Infant wide-field fundus photograph. 1240 by 1240 pixels. Acquired on the Phoenix ICON — 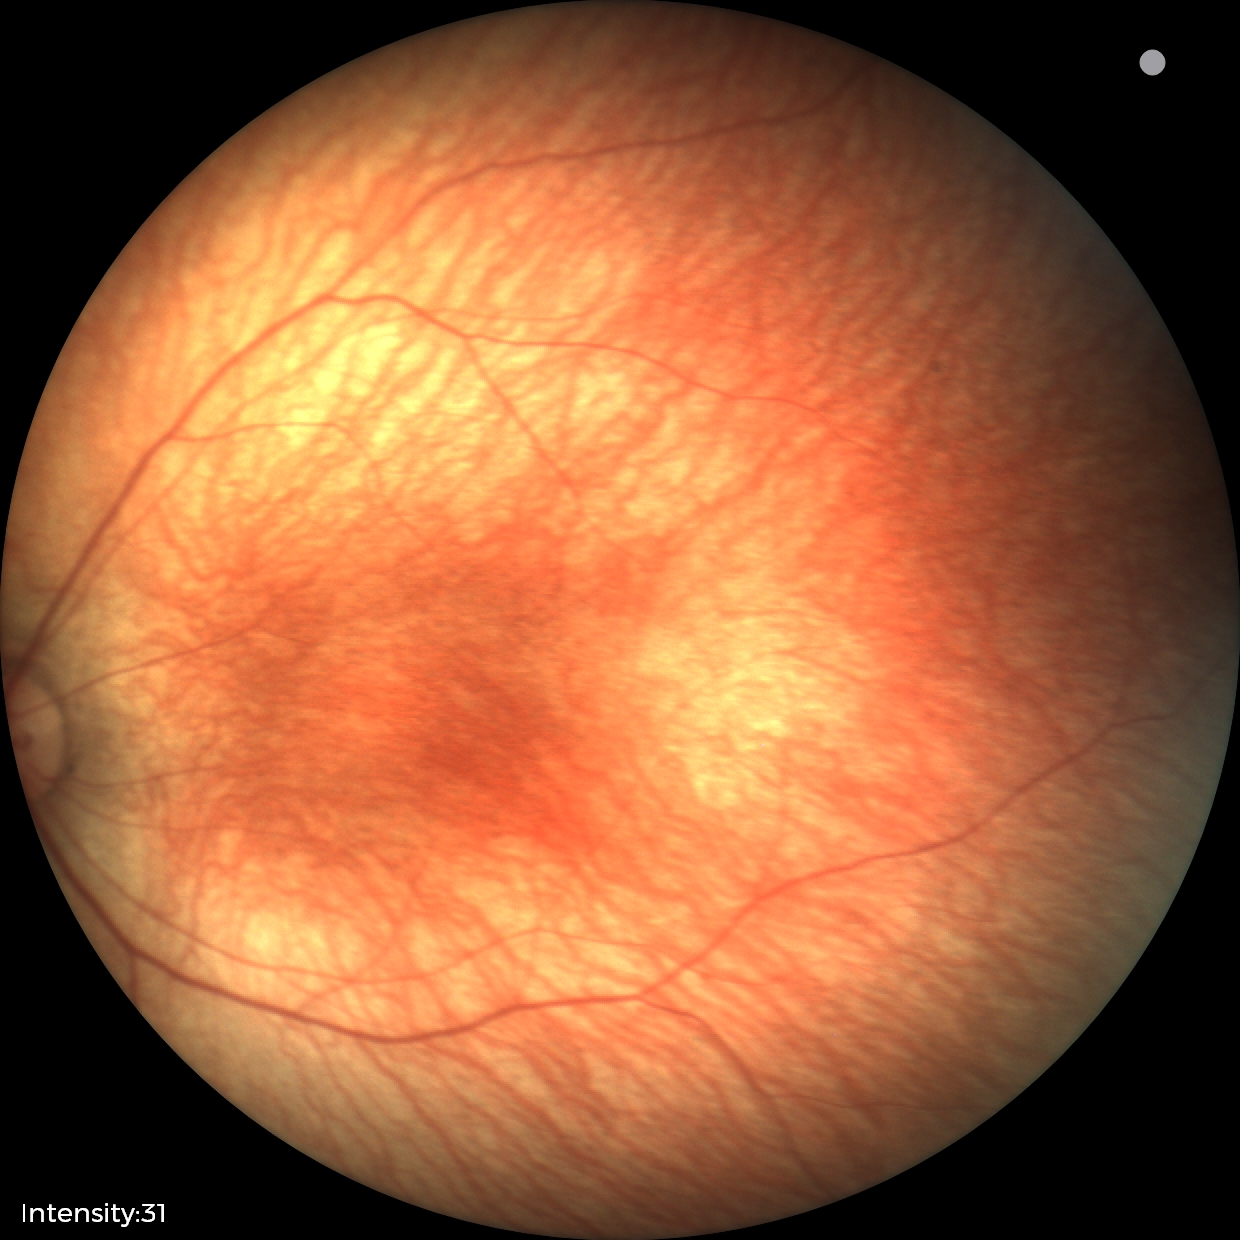

Assessment: no abnormal retinal findings.